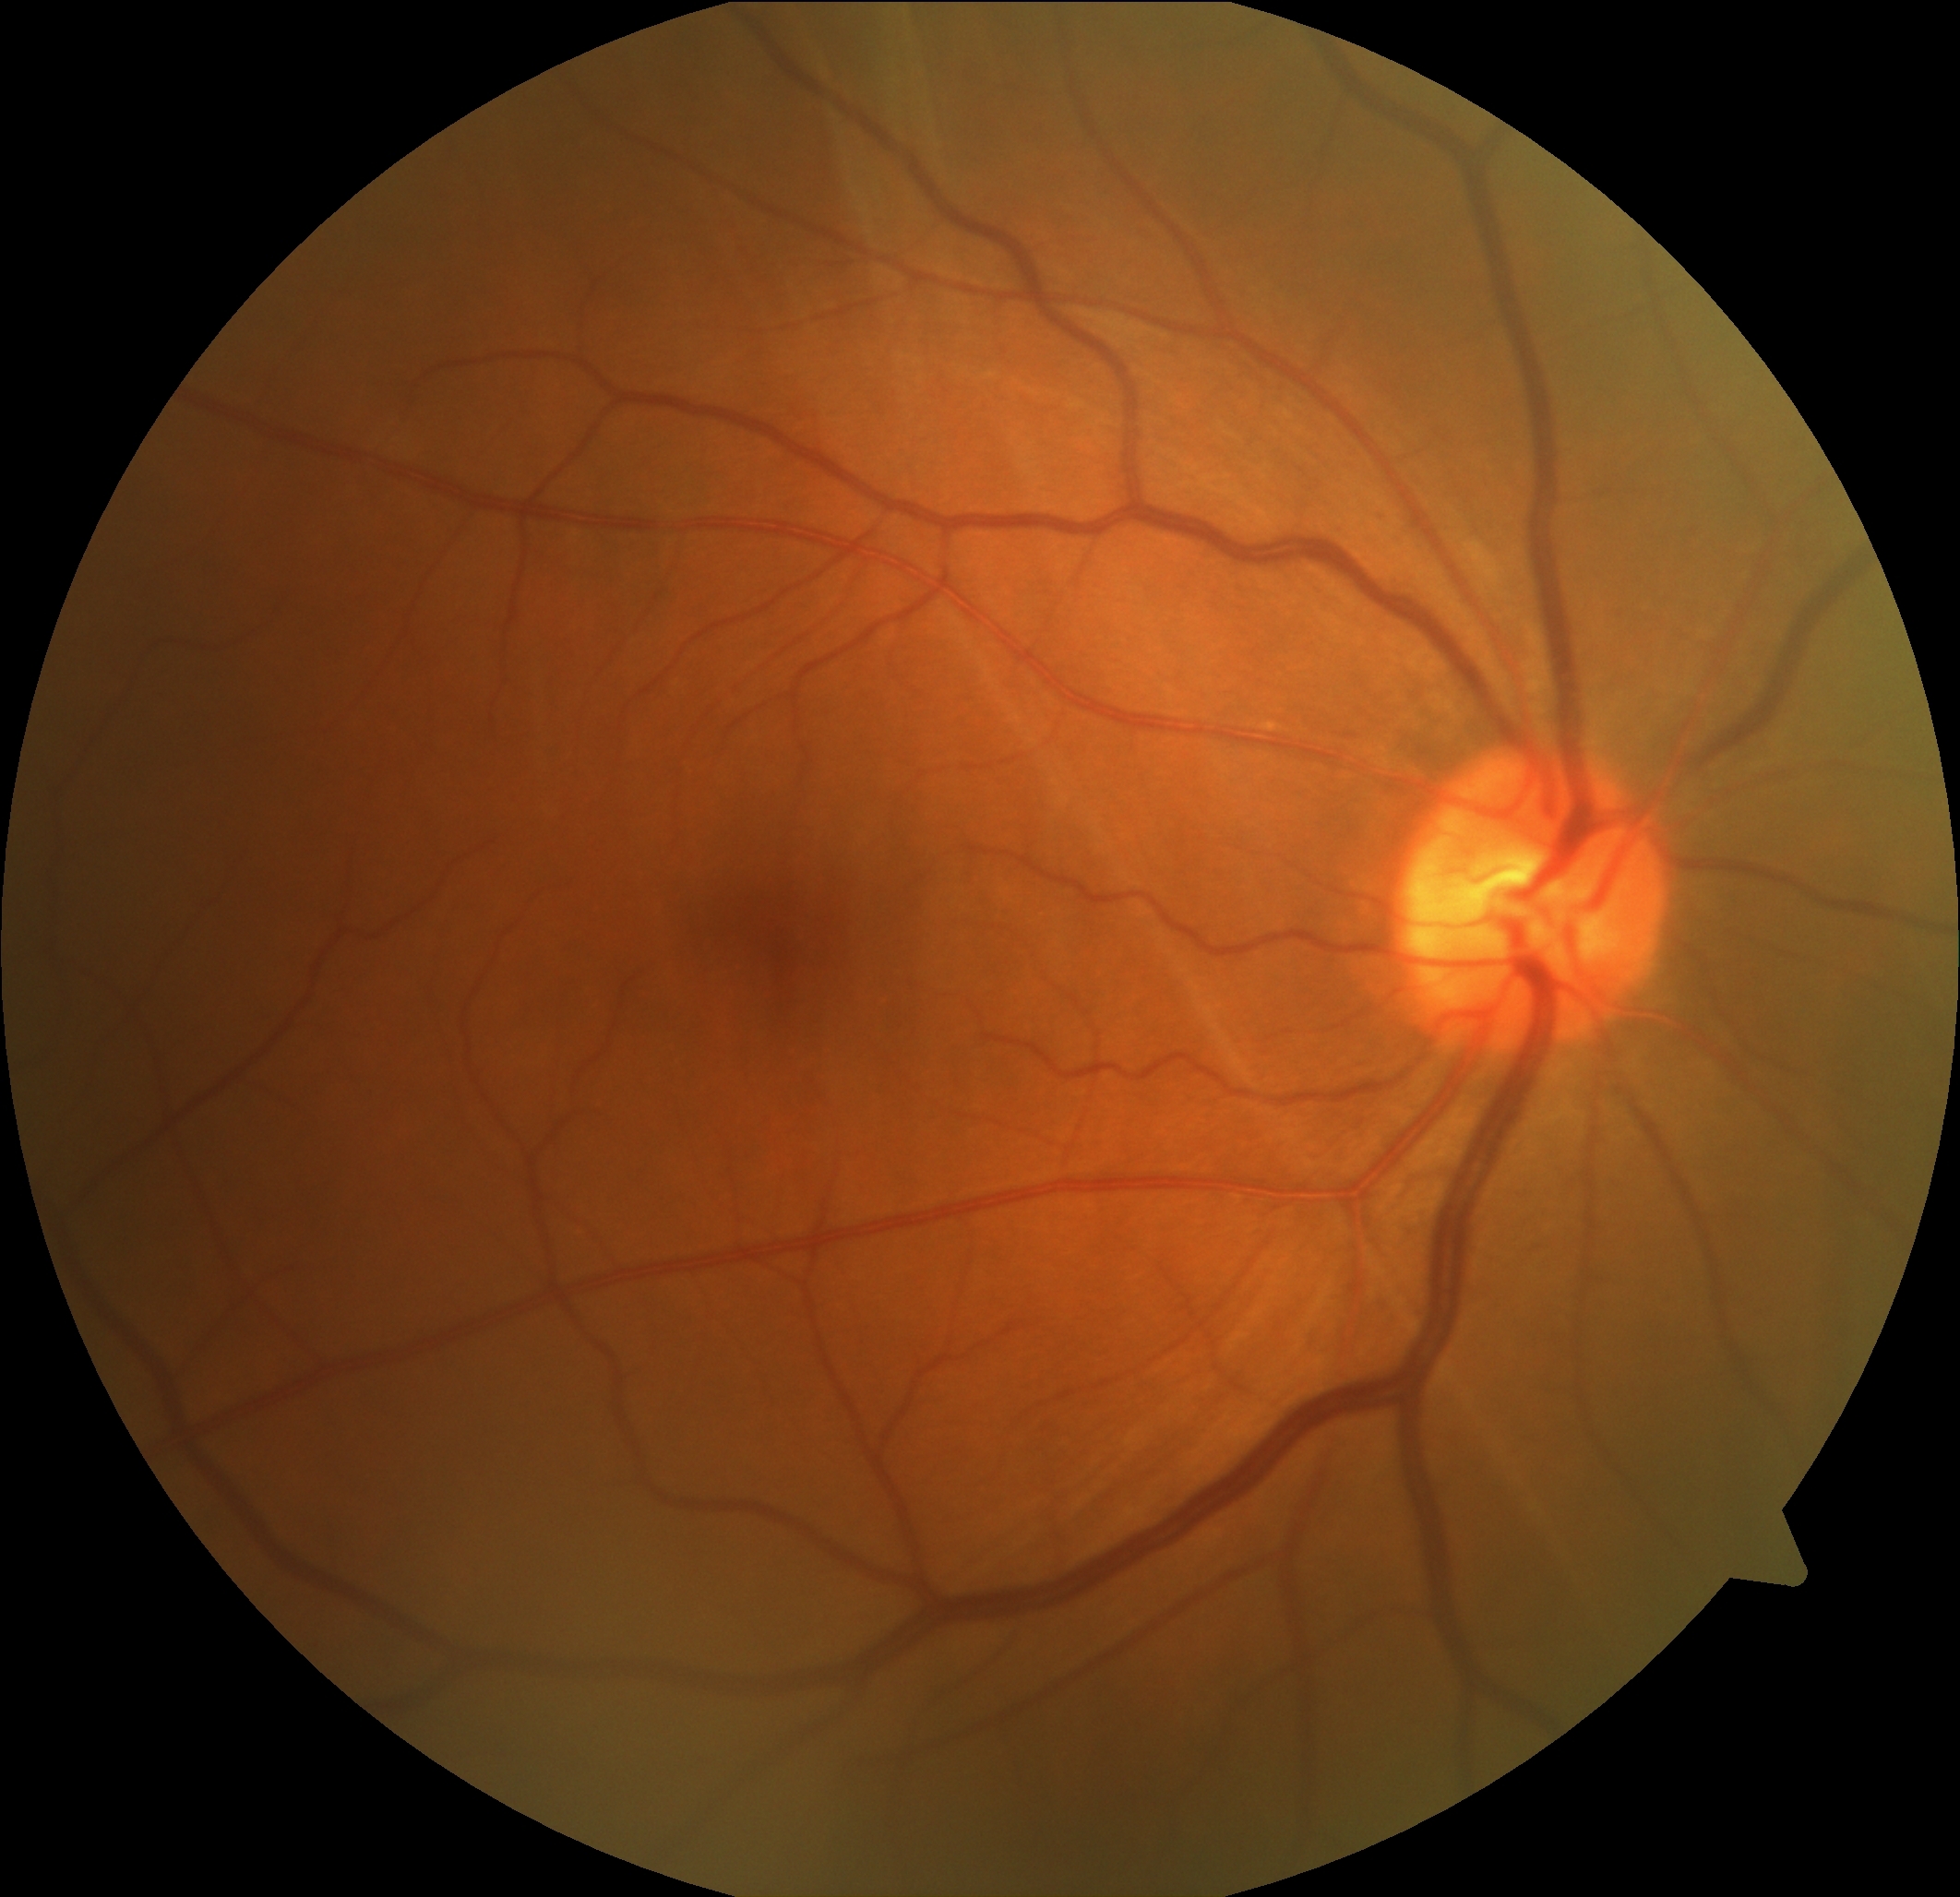
- diabetic retinopathy (DR) — 0